Camera: NIDEK AFC-230 — 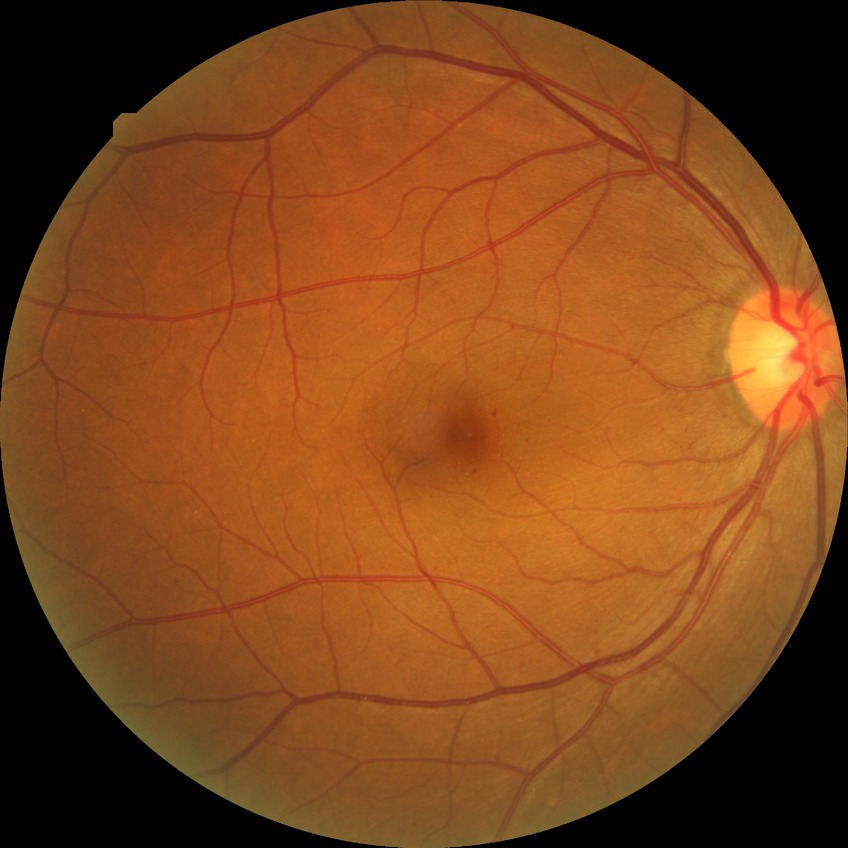 Diabetic retinopathy severity is no diabetic retinopathy.